45-degree field of view · 2048 by 1536 pixels: 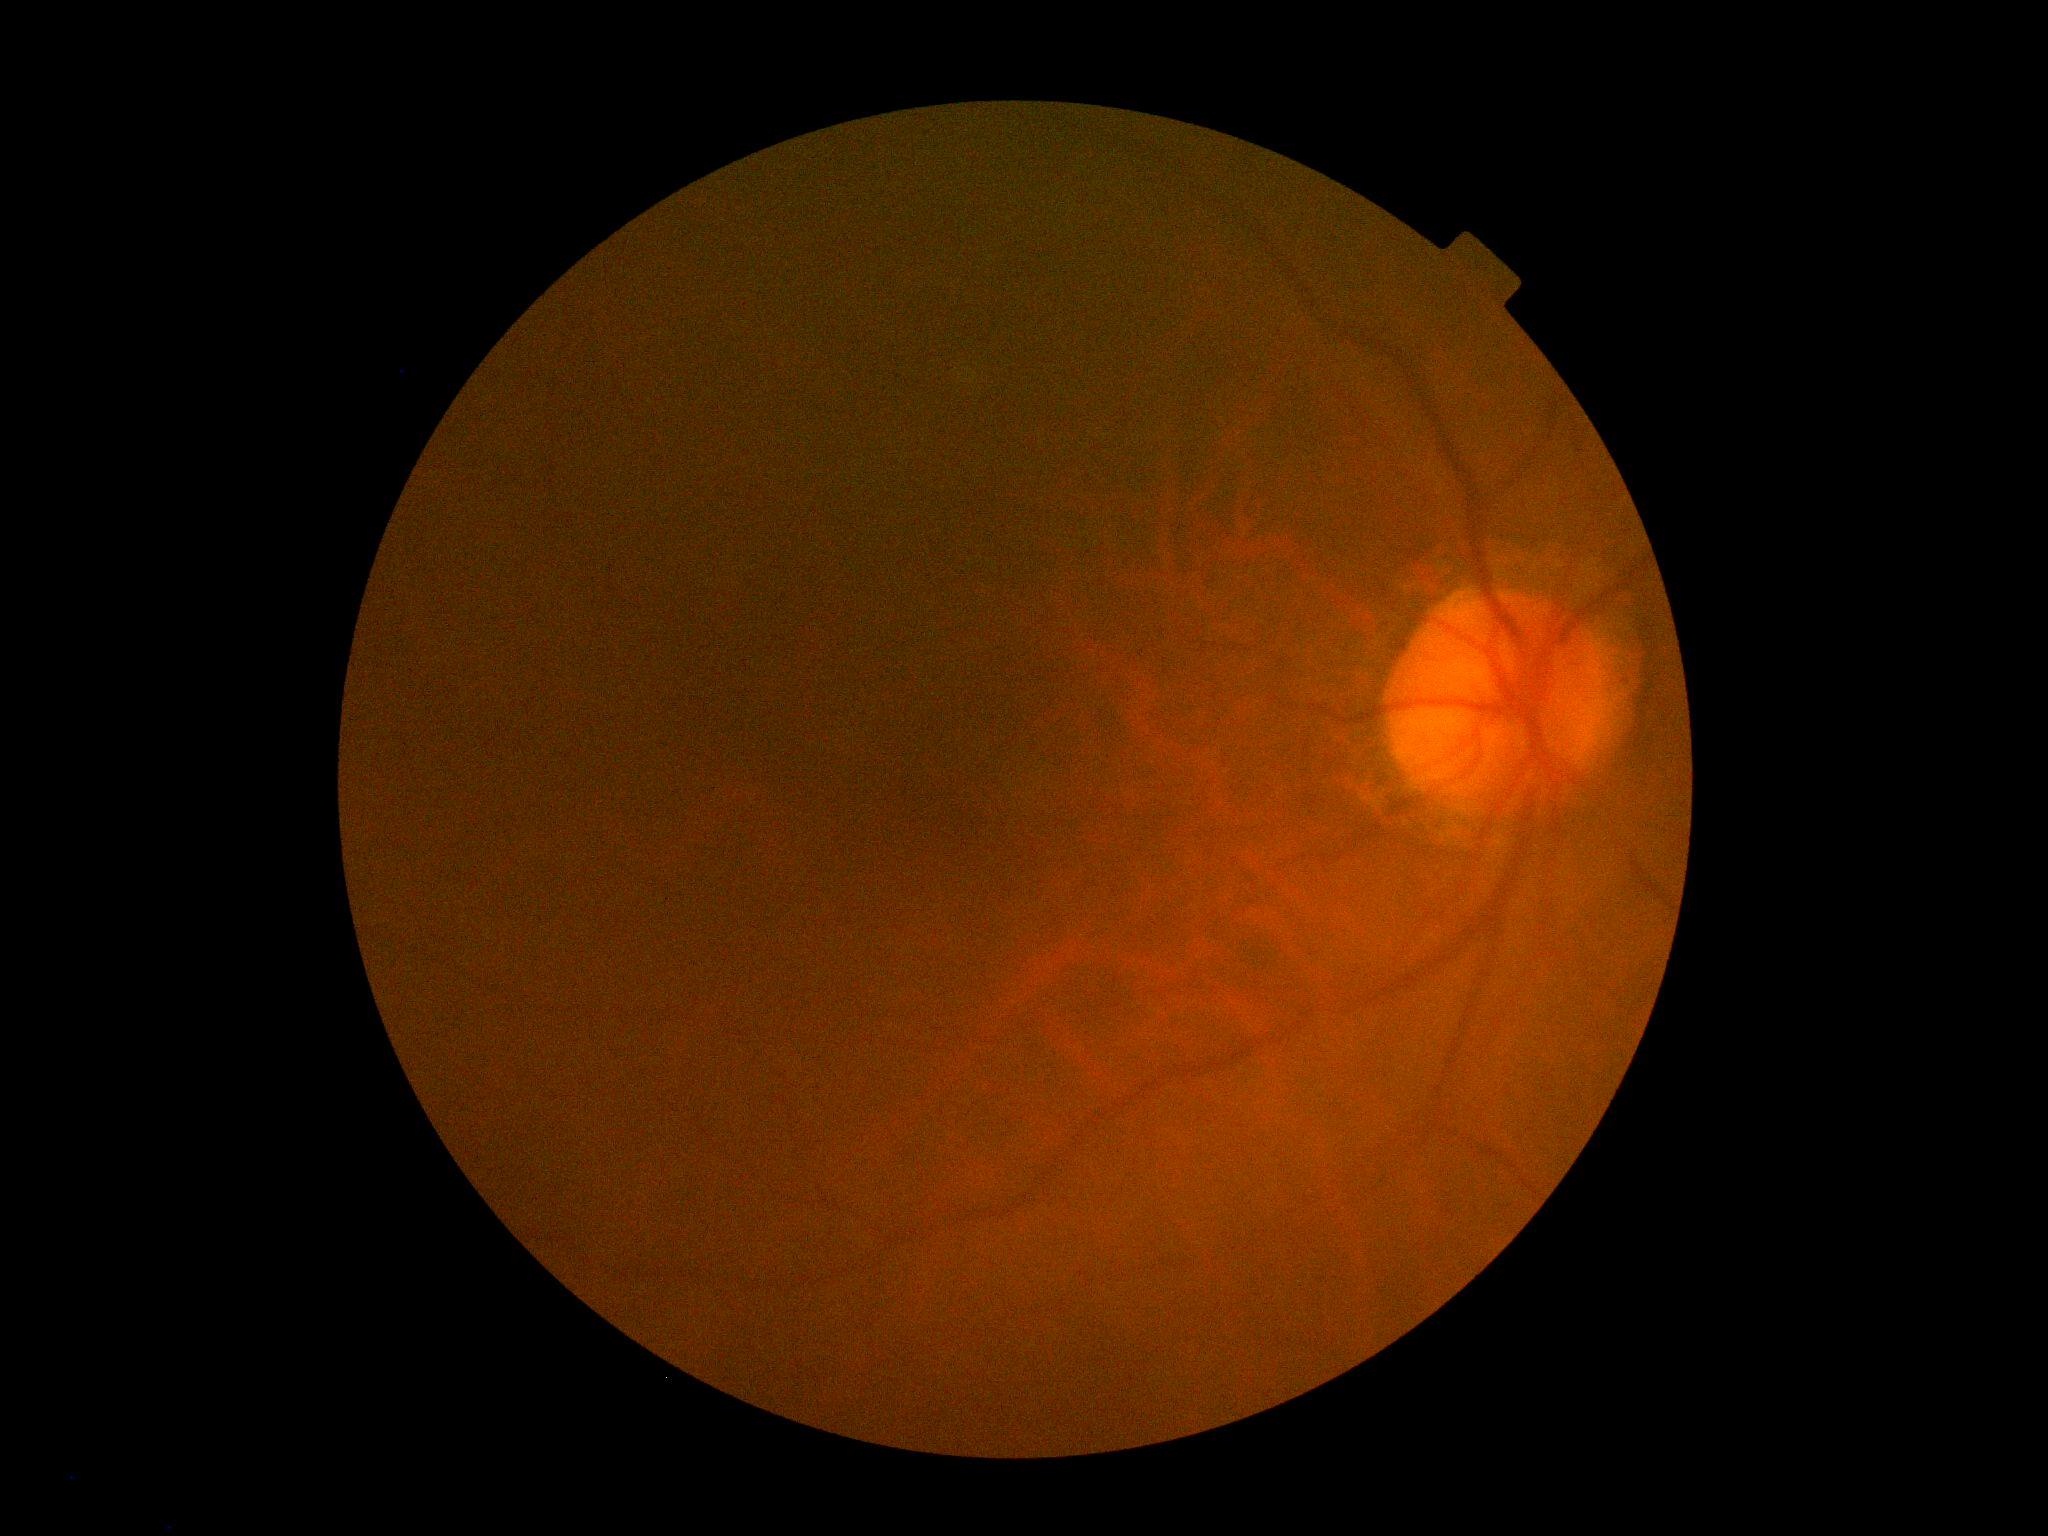

No signs of diabetic retinopathy.
DR grade is no apparent retinopathy (0).